Color fundus photograph. 1932 x 1932 pixels. Macula at the center of the field:
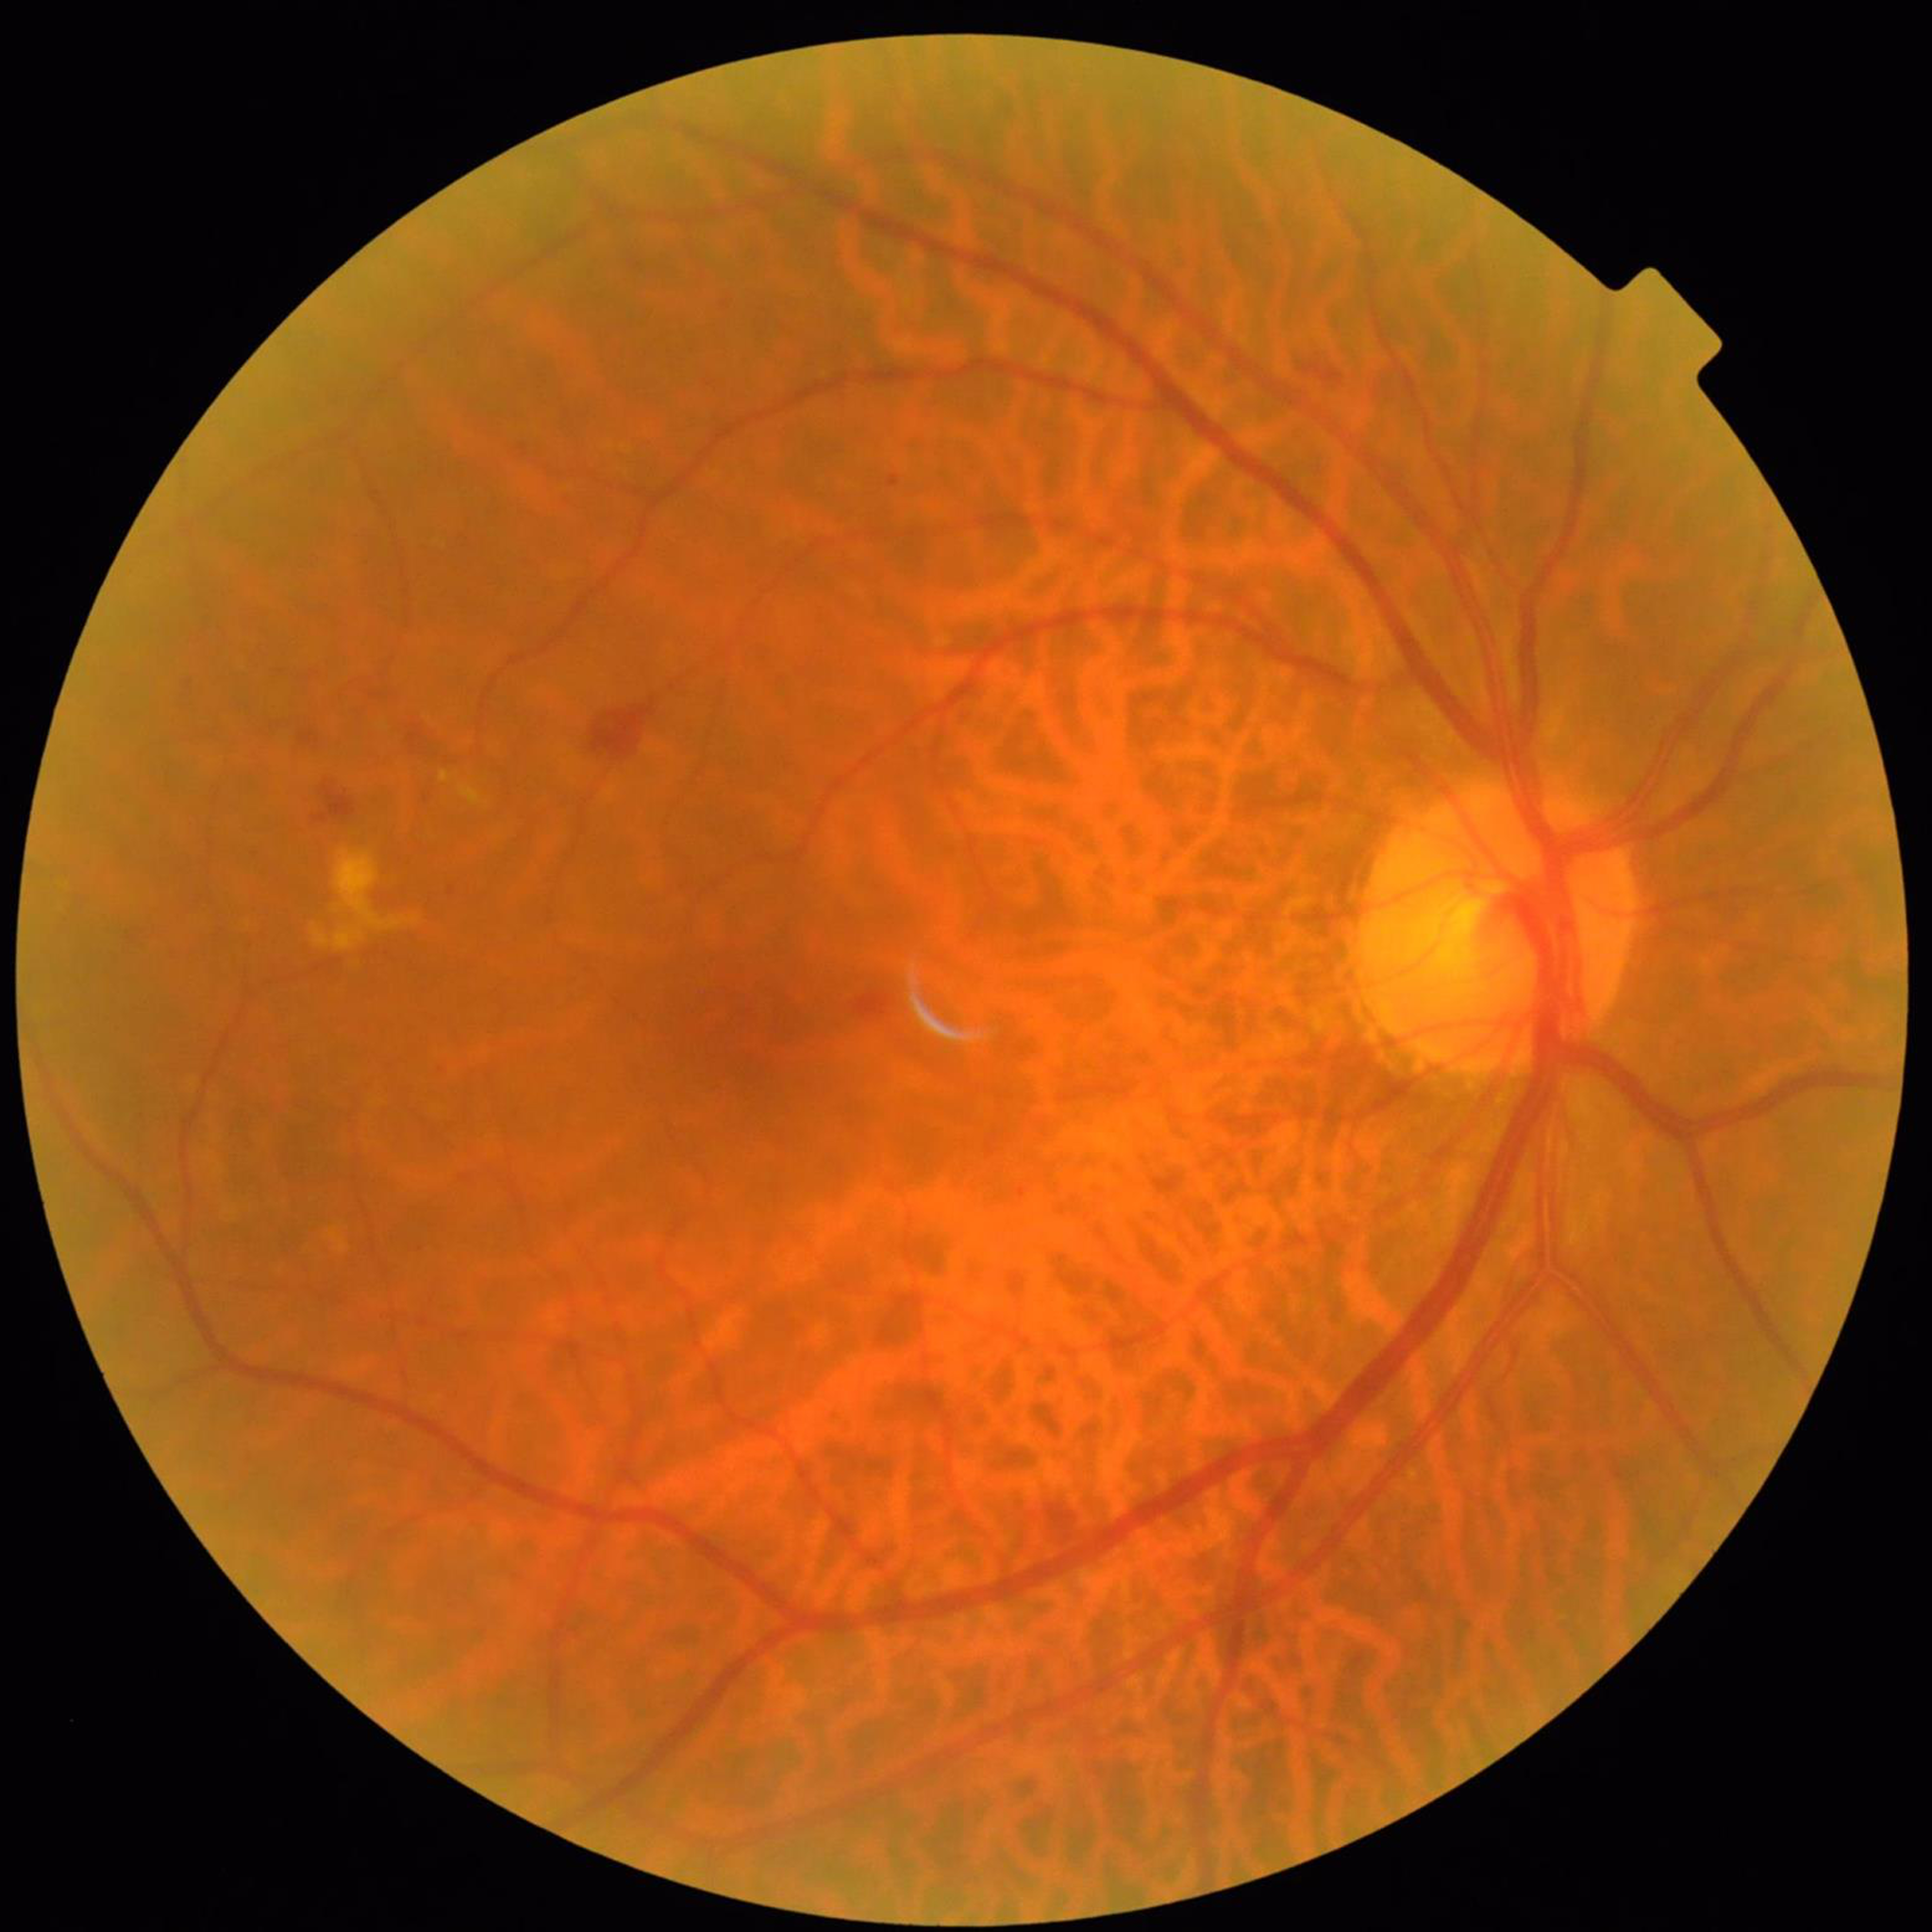

Image quality: good; Clinical diagnosis: diabetic retinopathy.